848x848px: 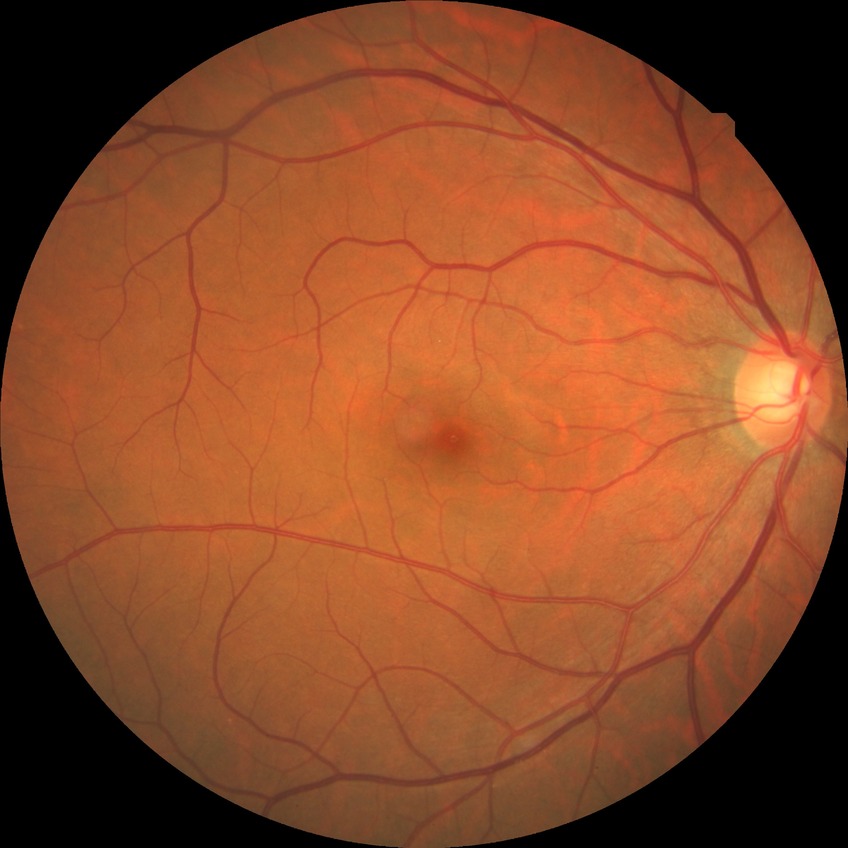 {
  "davis_grade": "no diabetic retinopathy"
}